Diabetic retinopathy graded by the modified Davis classification · without pupil dilation:
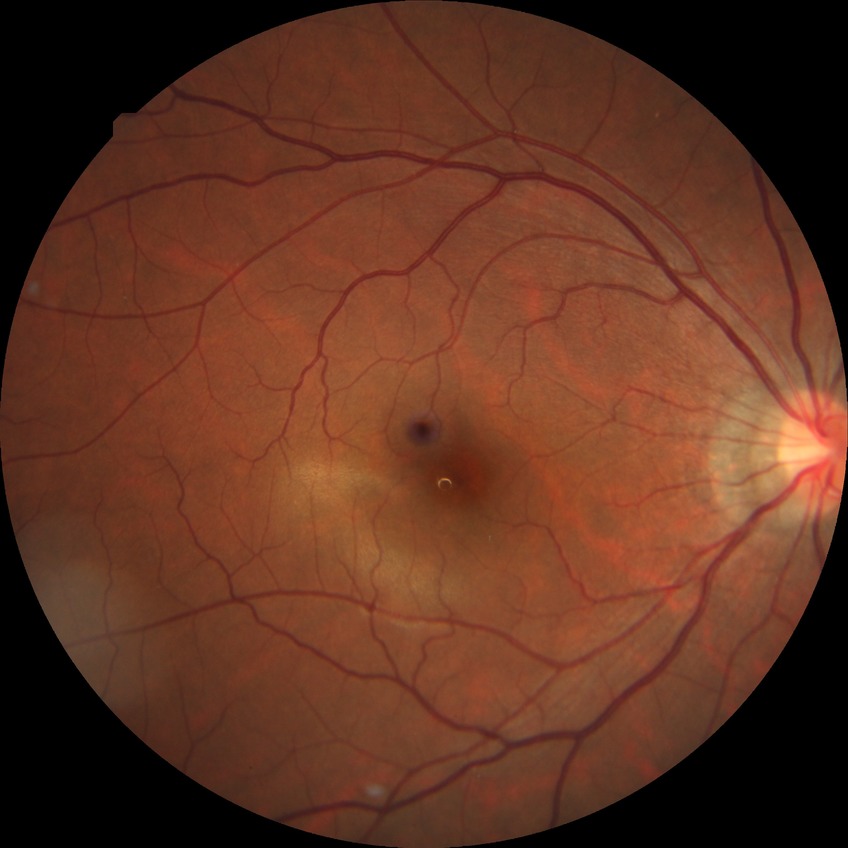 diabetic retinopathy (DR) = NDR (no diabetic retinopathy).